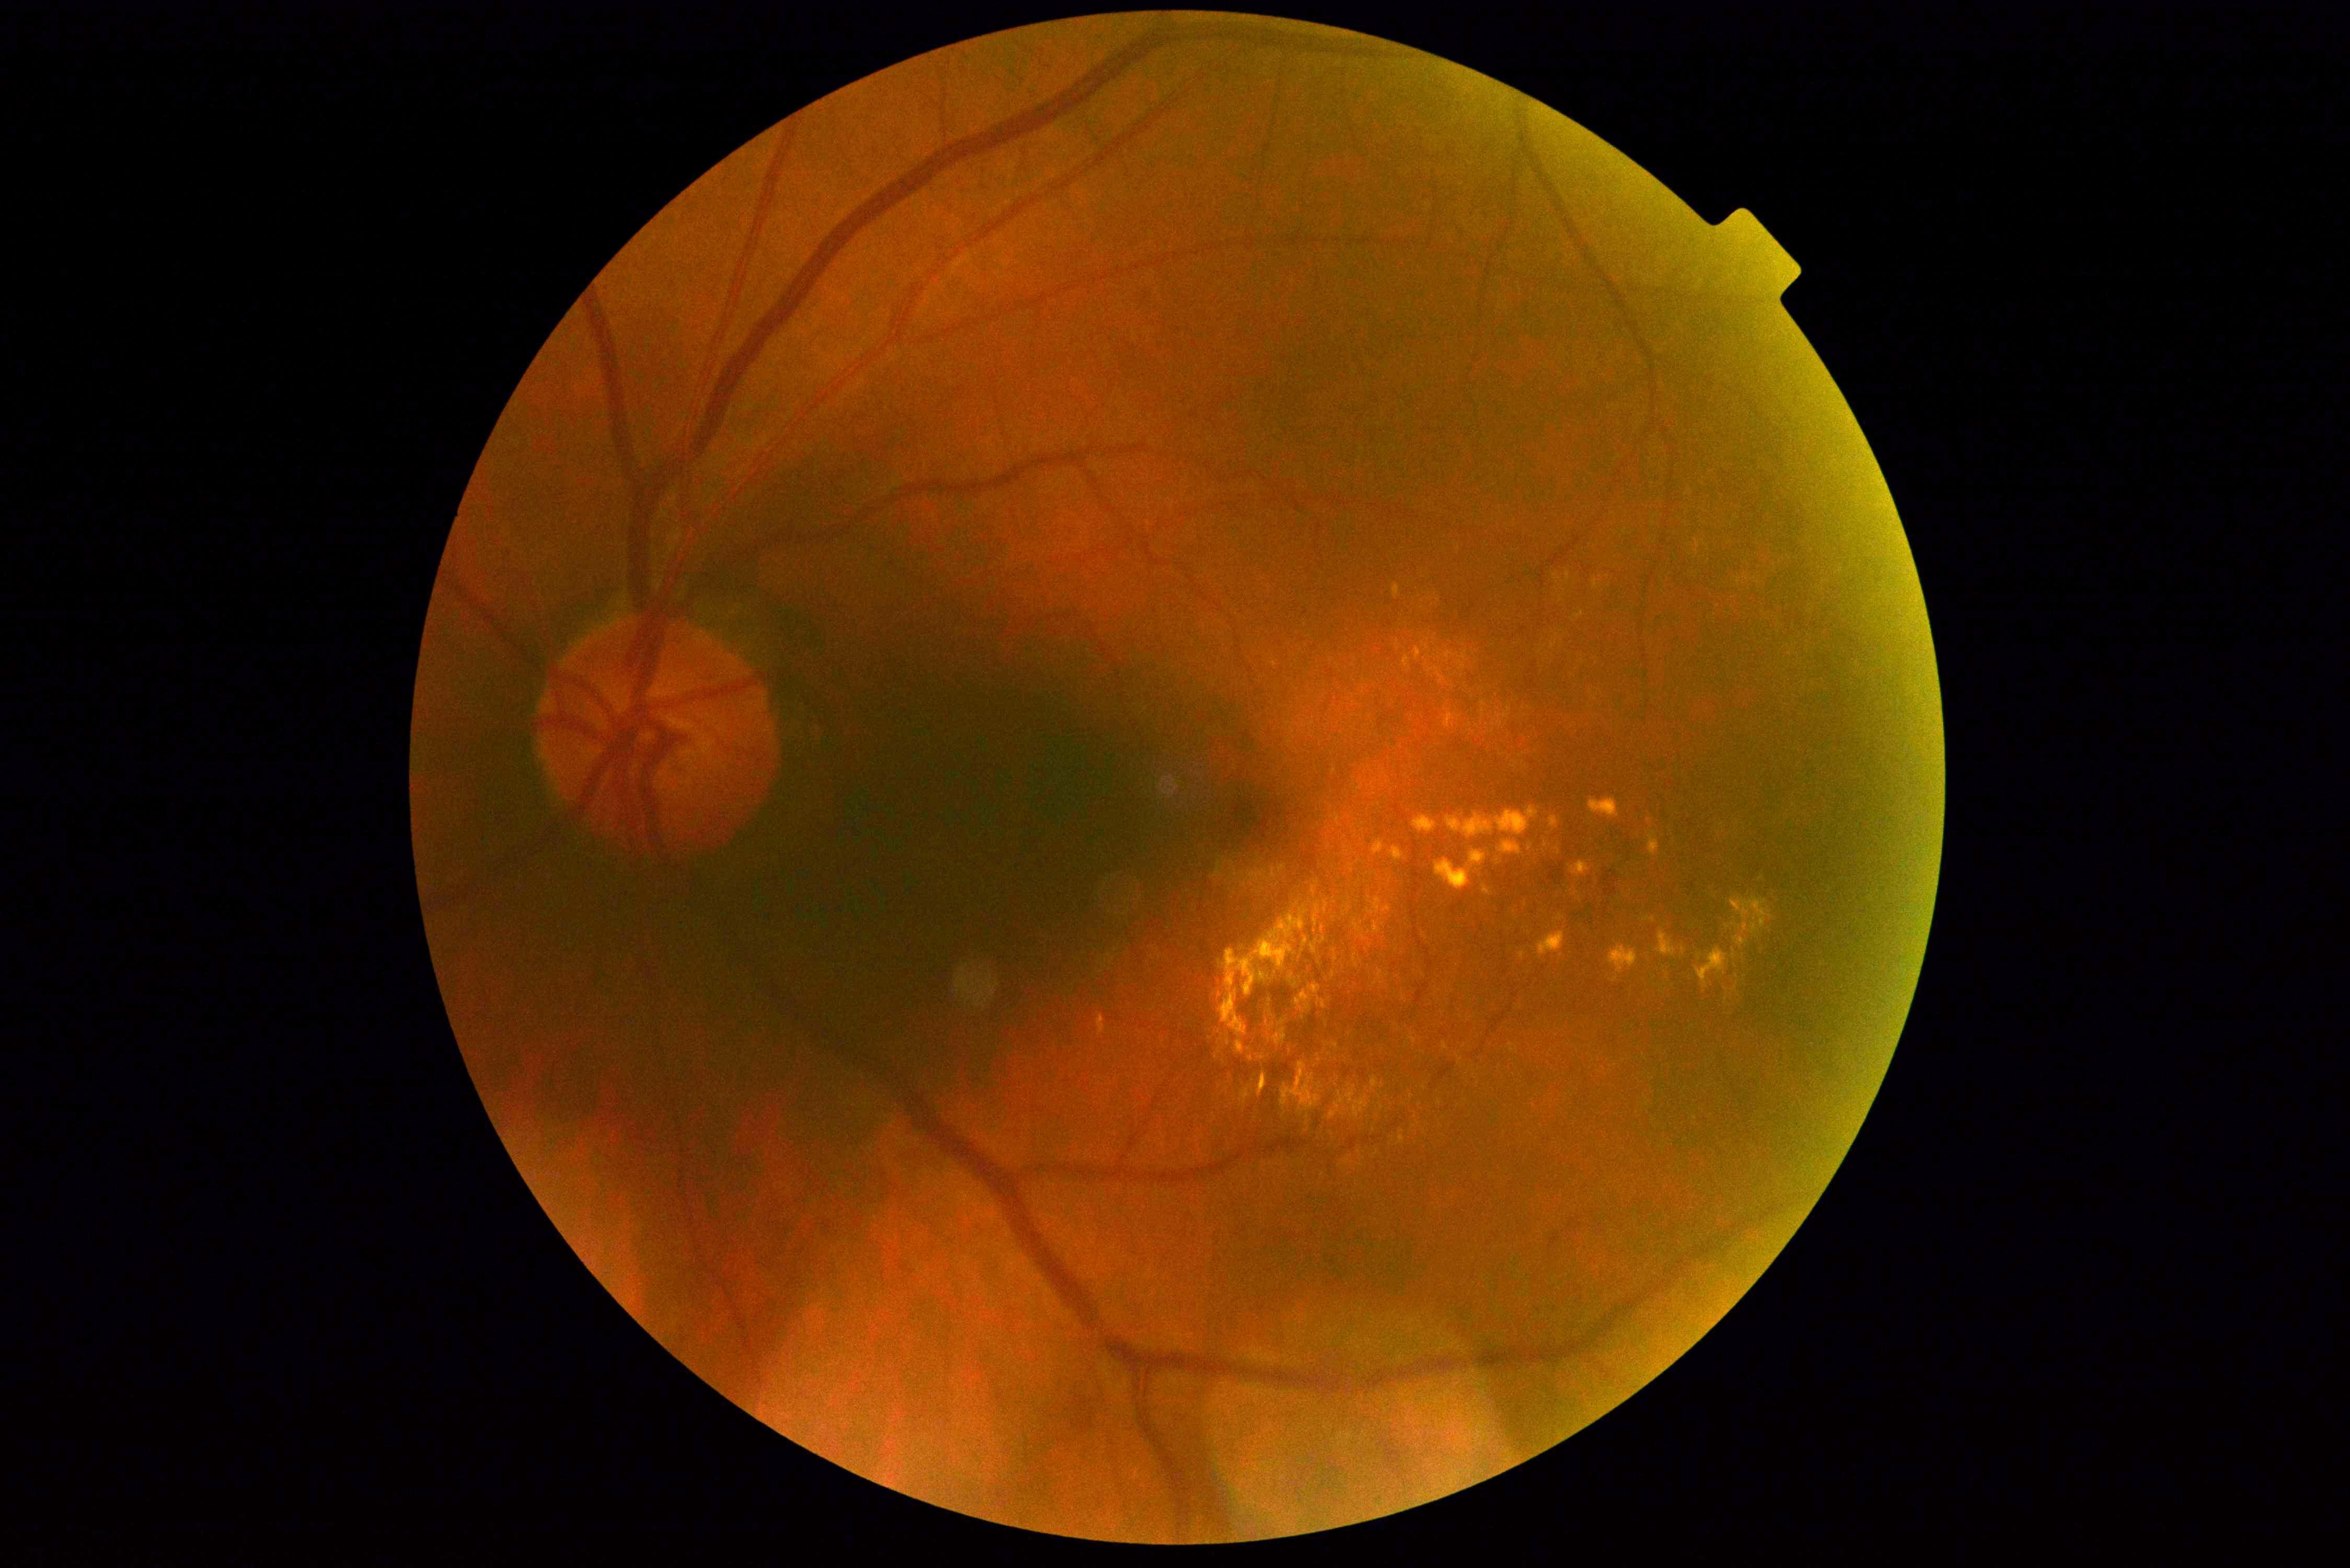

DR stage is grade 2 (moderate NPDR).